Nidek AFC-330. Optic disc region crop.
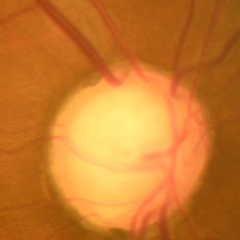 Glaucomatous changes are present. Impression = early-stage glaucoma.